Captured with the Clarity RetCam 3 (130° field of view) · wide-field fundus photograph from neonatal ROP screening: 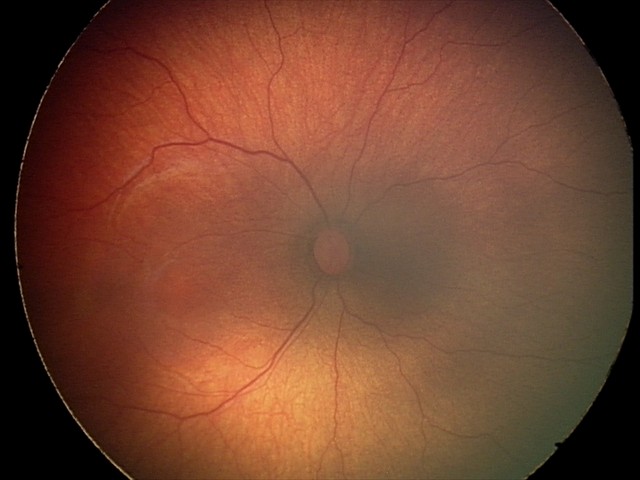 No plus disease. Series diagnosed as retinopathy of prematurity stage 2.